Centered on the macula. Captured on a Topcon TRC-NW8 fundus camera
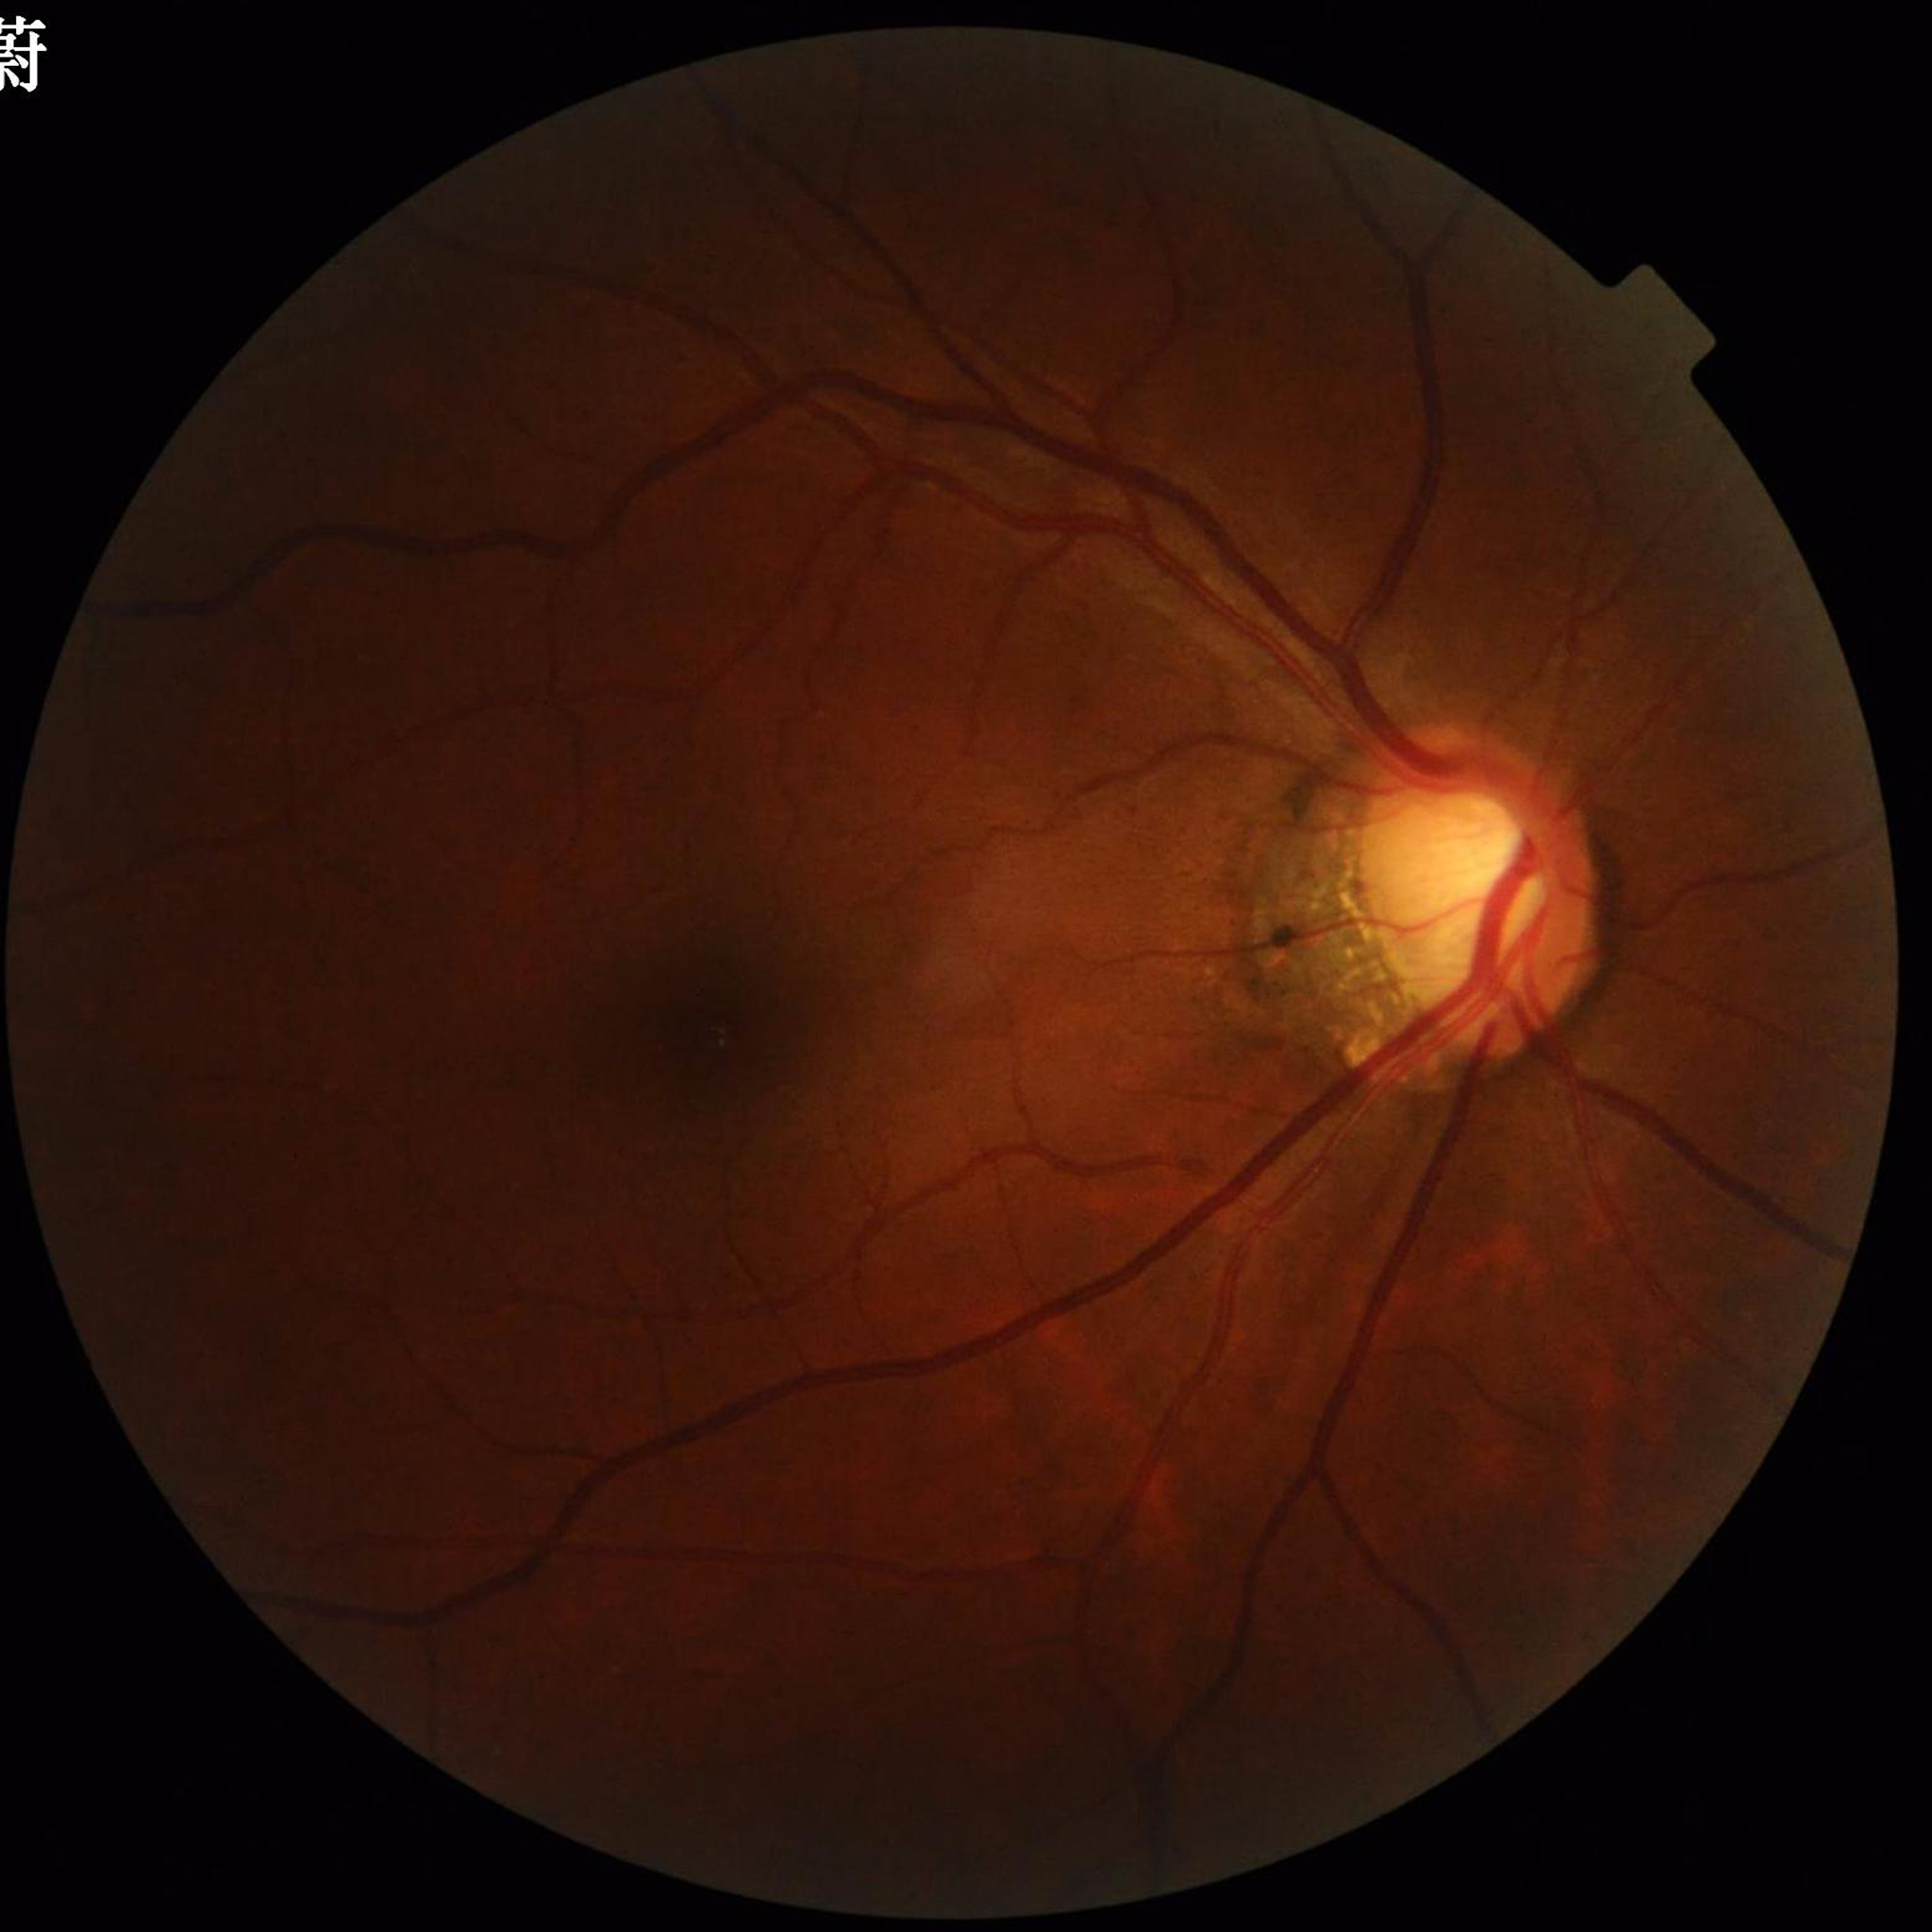 Clinical diagnosis: glaucoma.